1240x1240; Phoenix ICON, 100° FOV; wide-field fundus photograph from neonatal ROP screening — 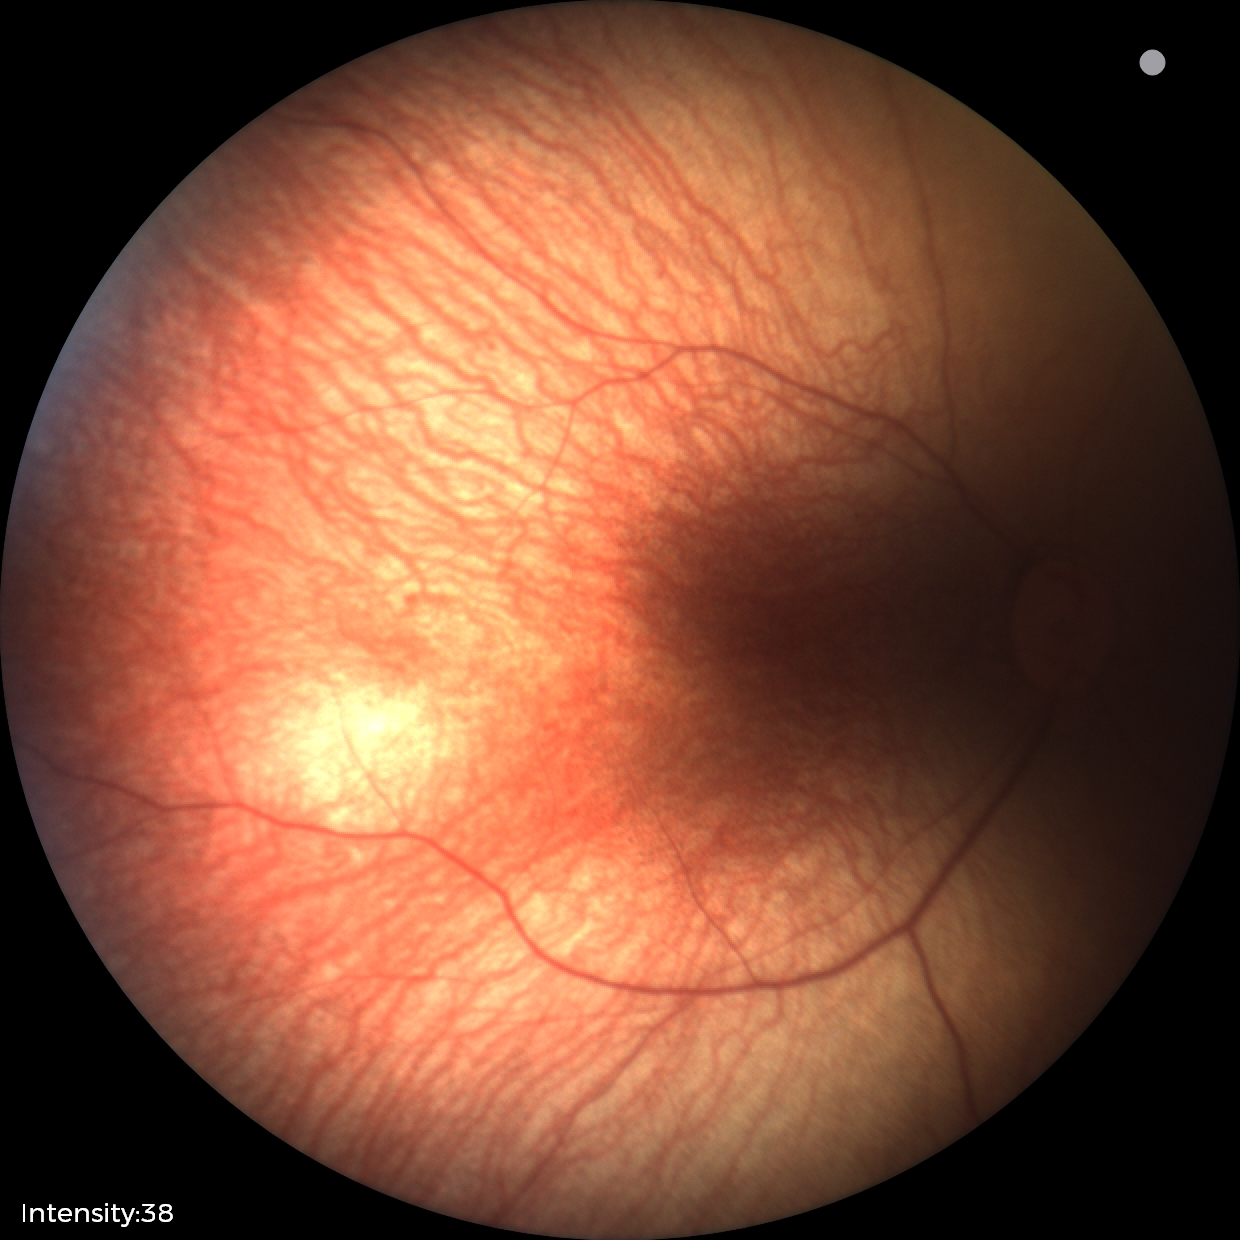 Examination with physiological retinal findings.